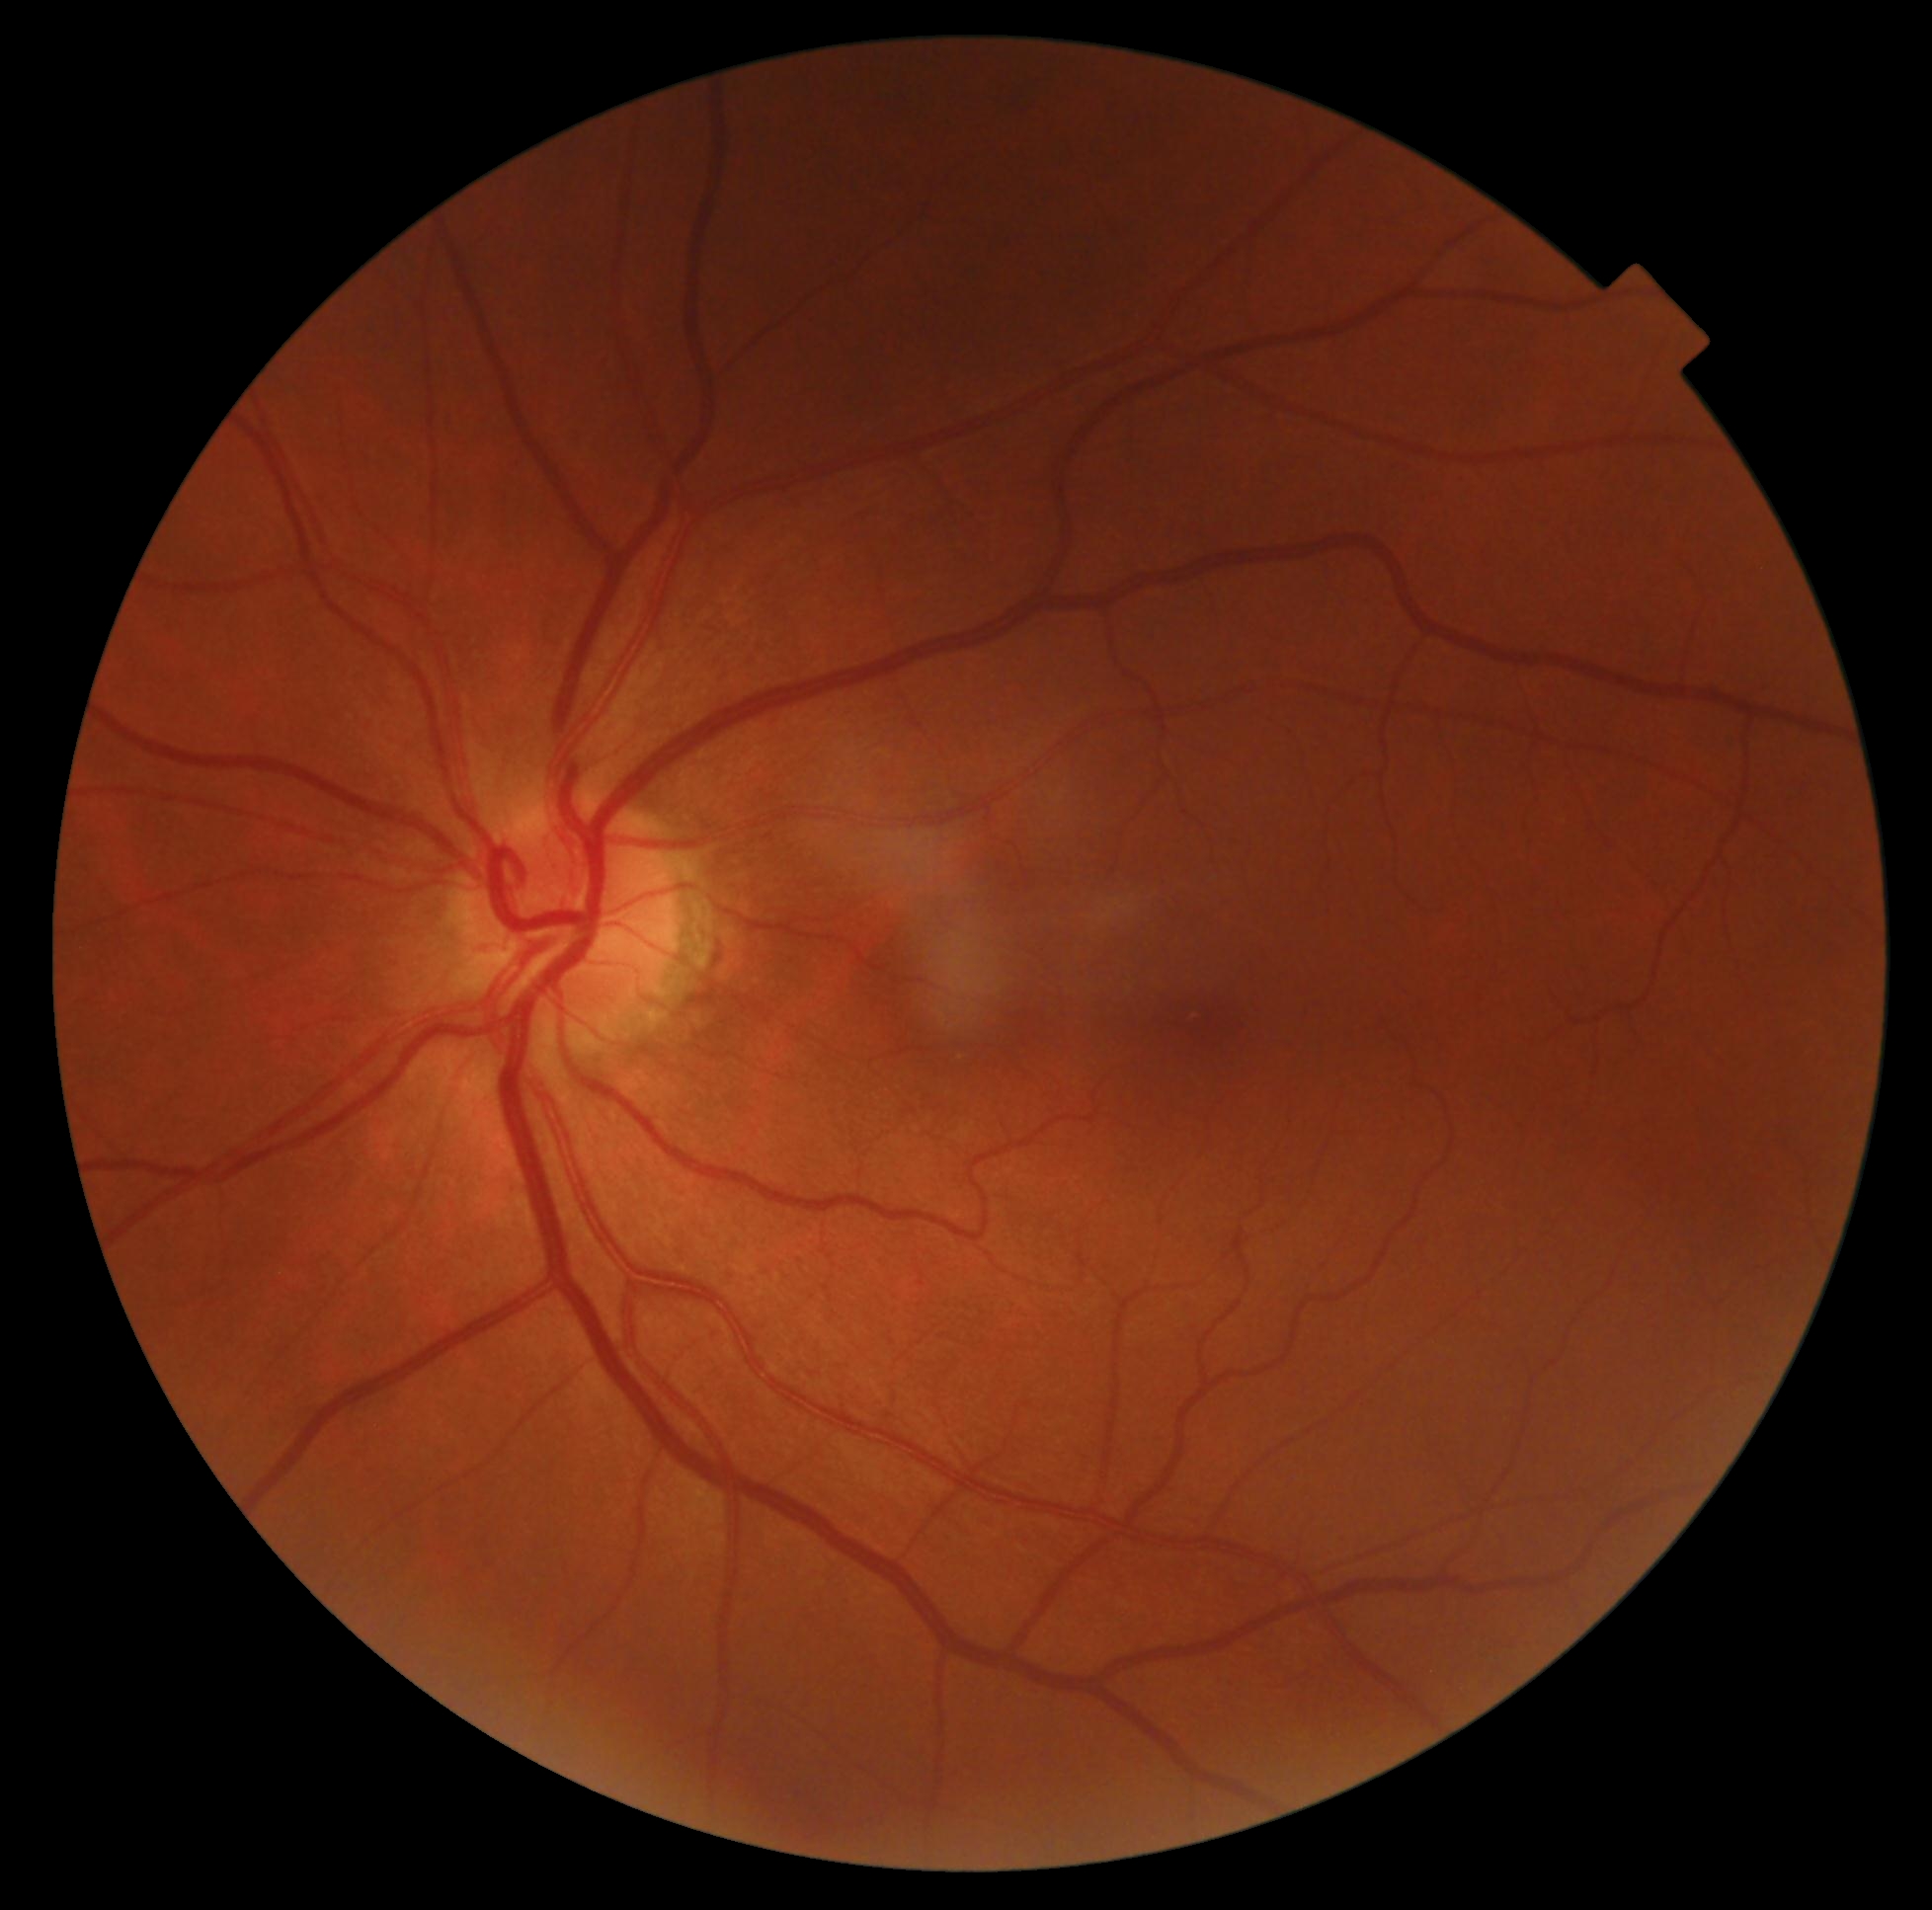

diabetic retinopathy severity=grade 0.